Fundus photo
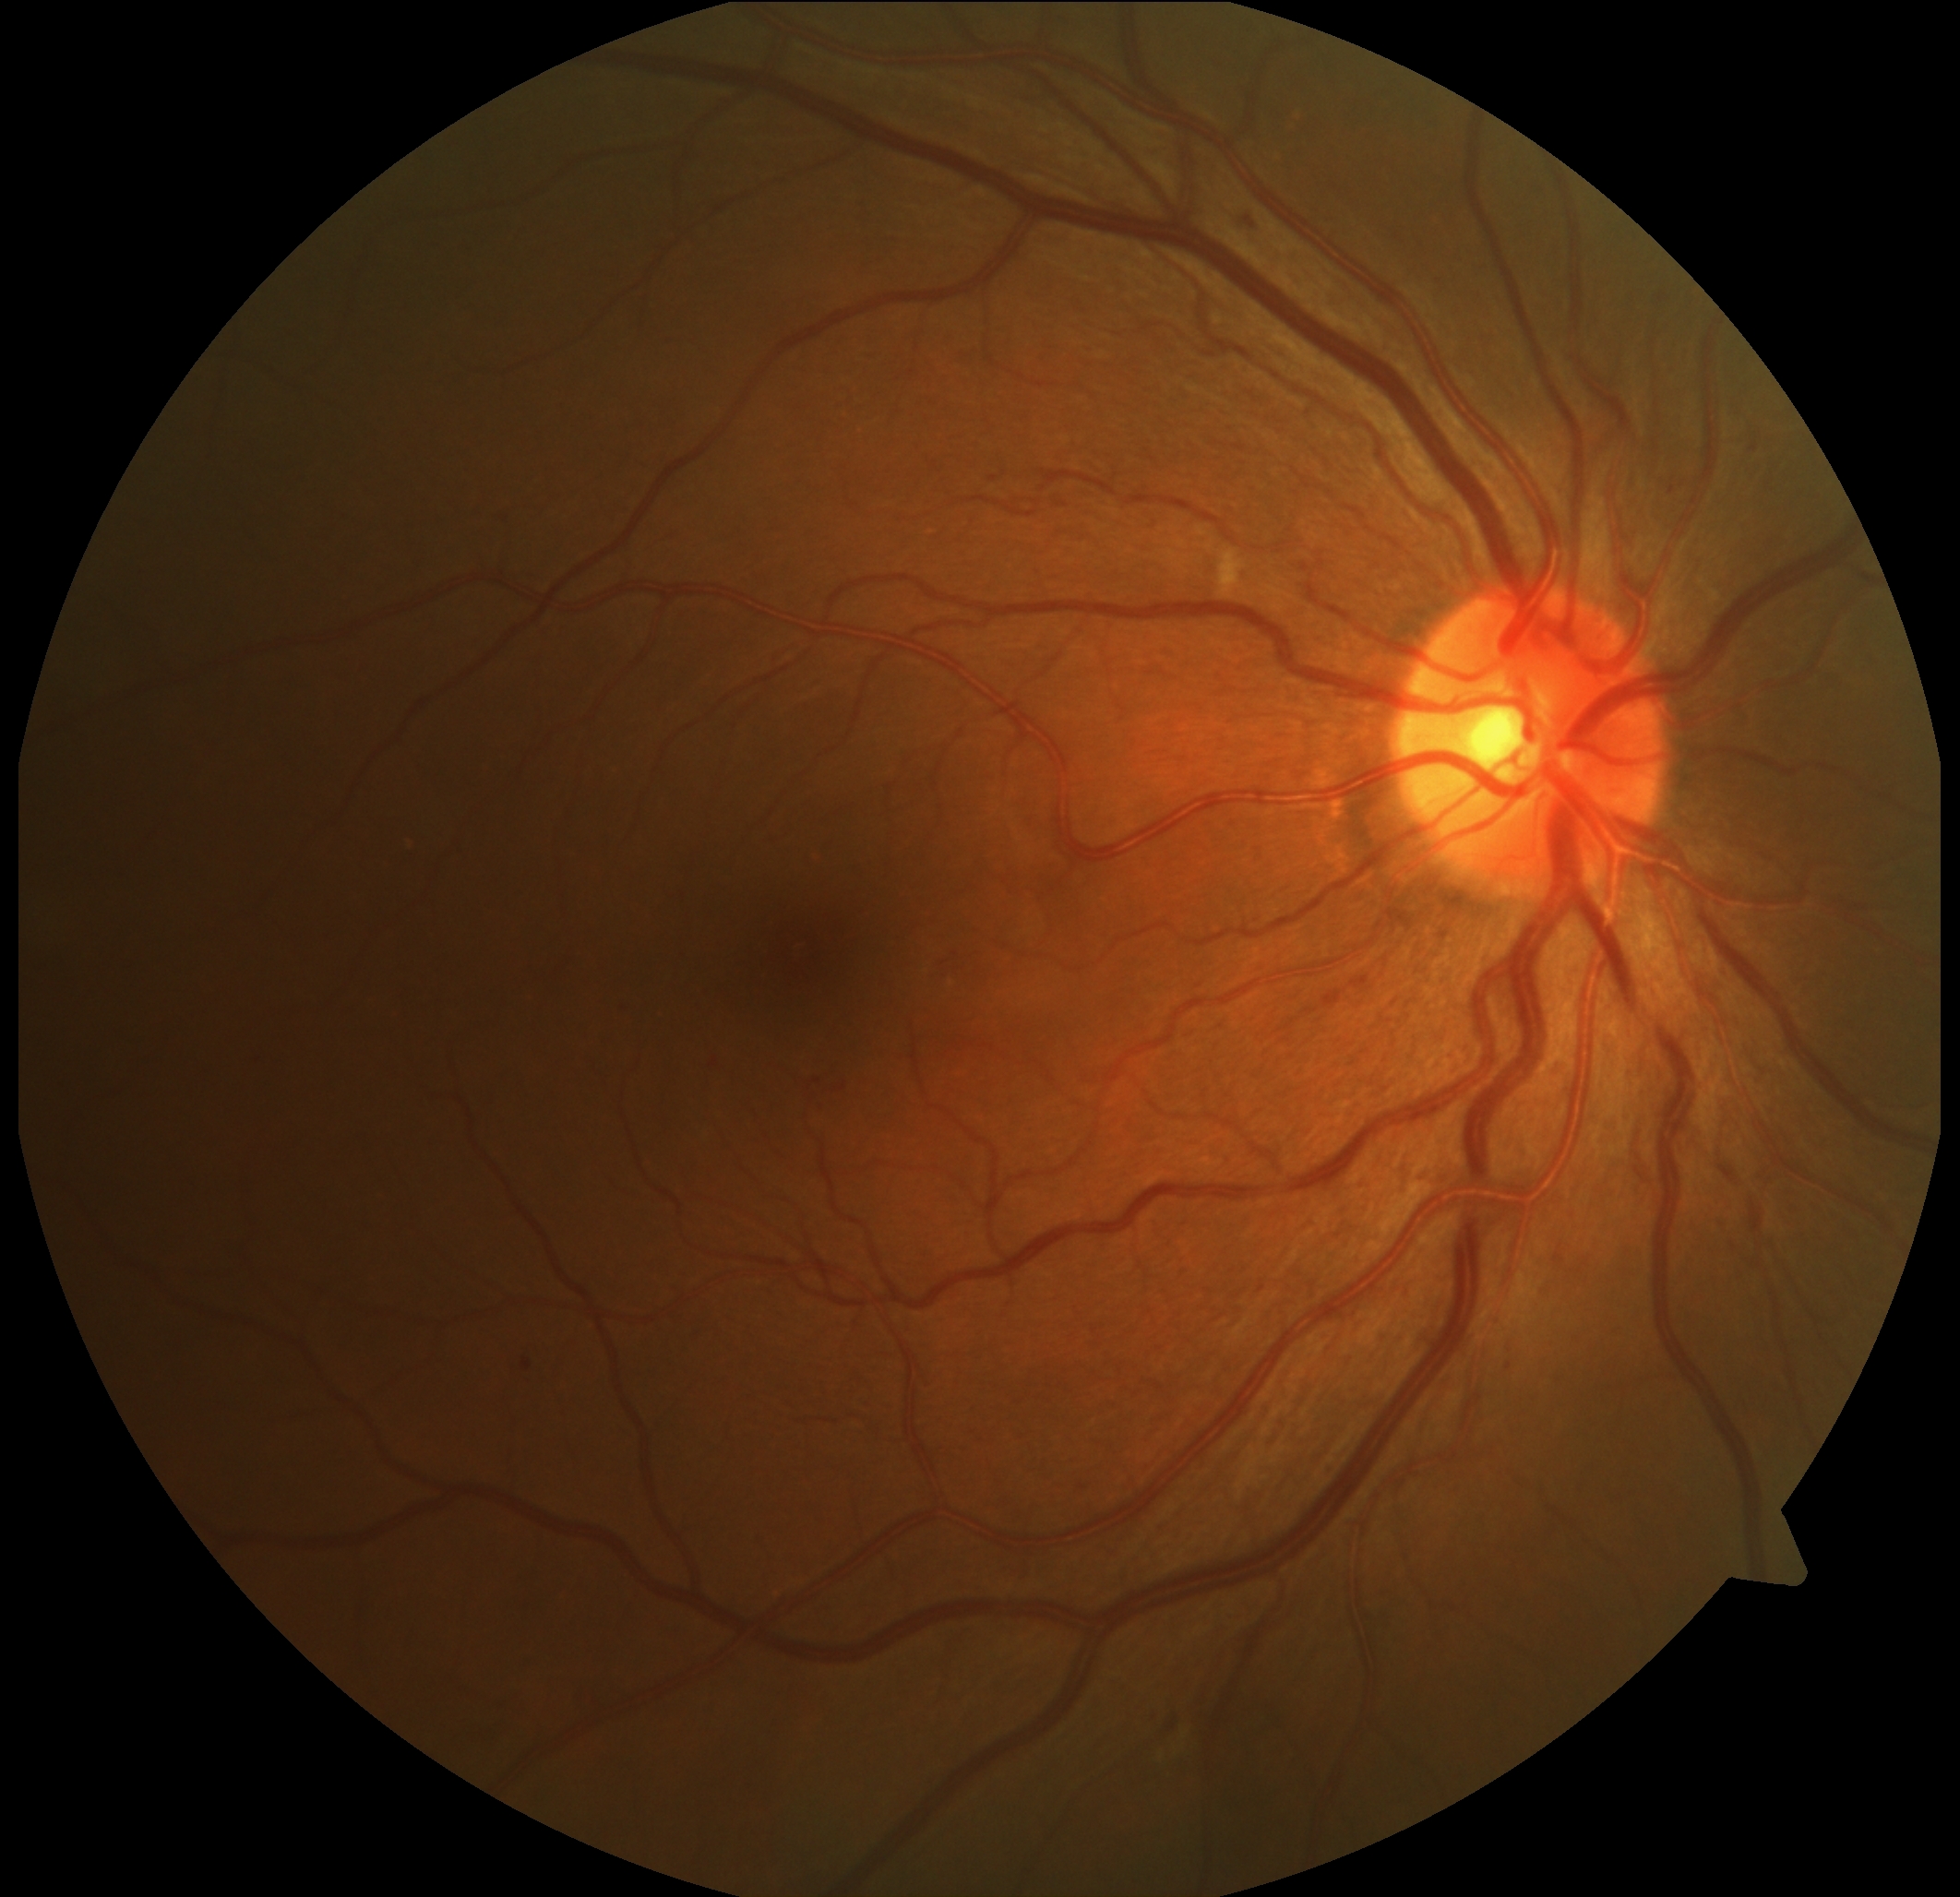 Diabetic retinopathy: 2/4.